1932x1932 · mydriatic (tropicamide phenylephrine 1.0%) — 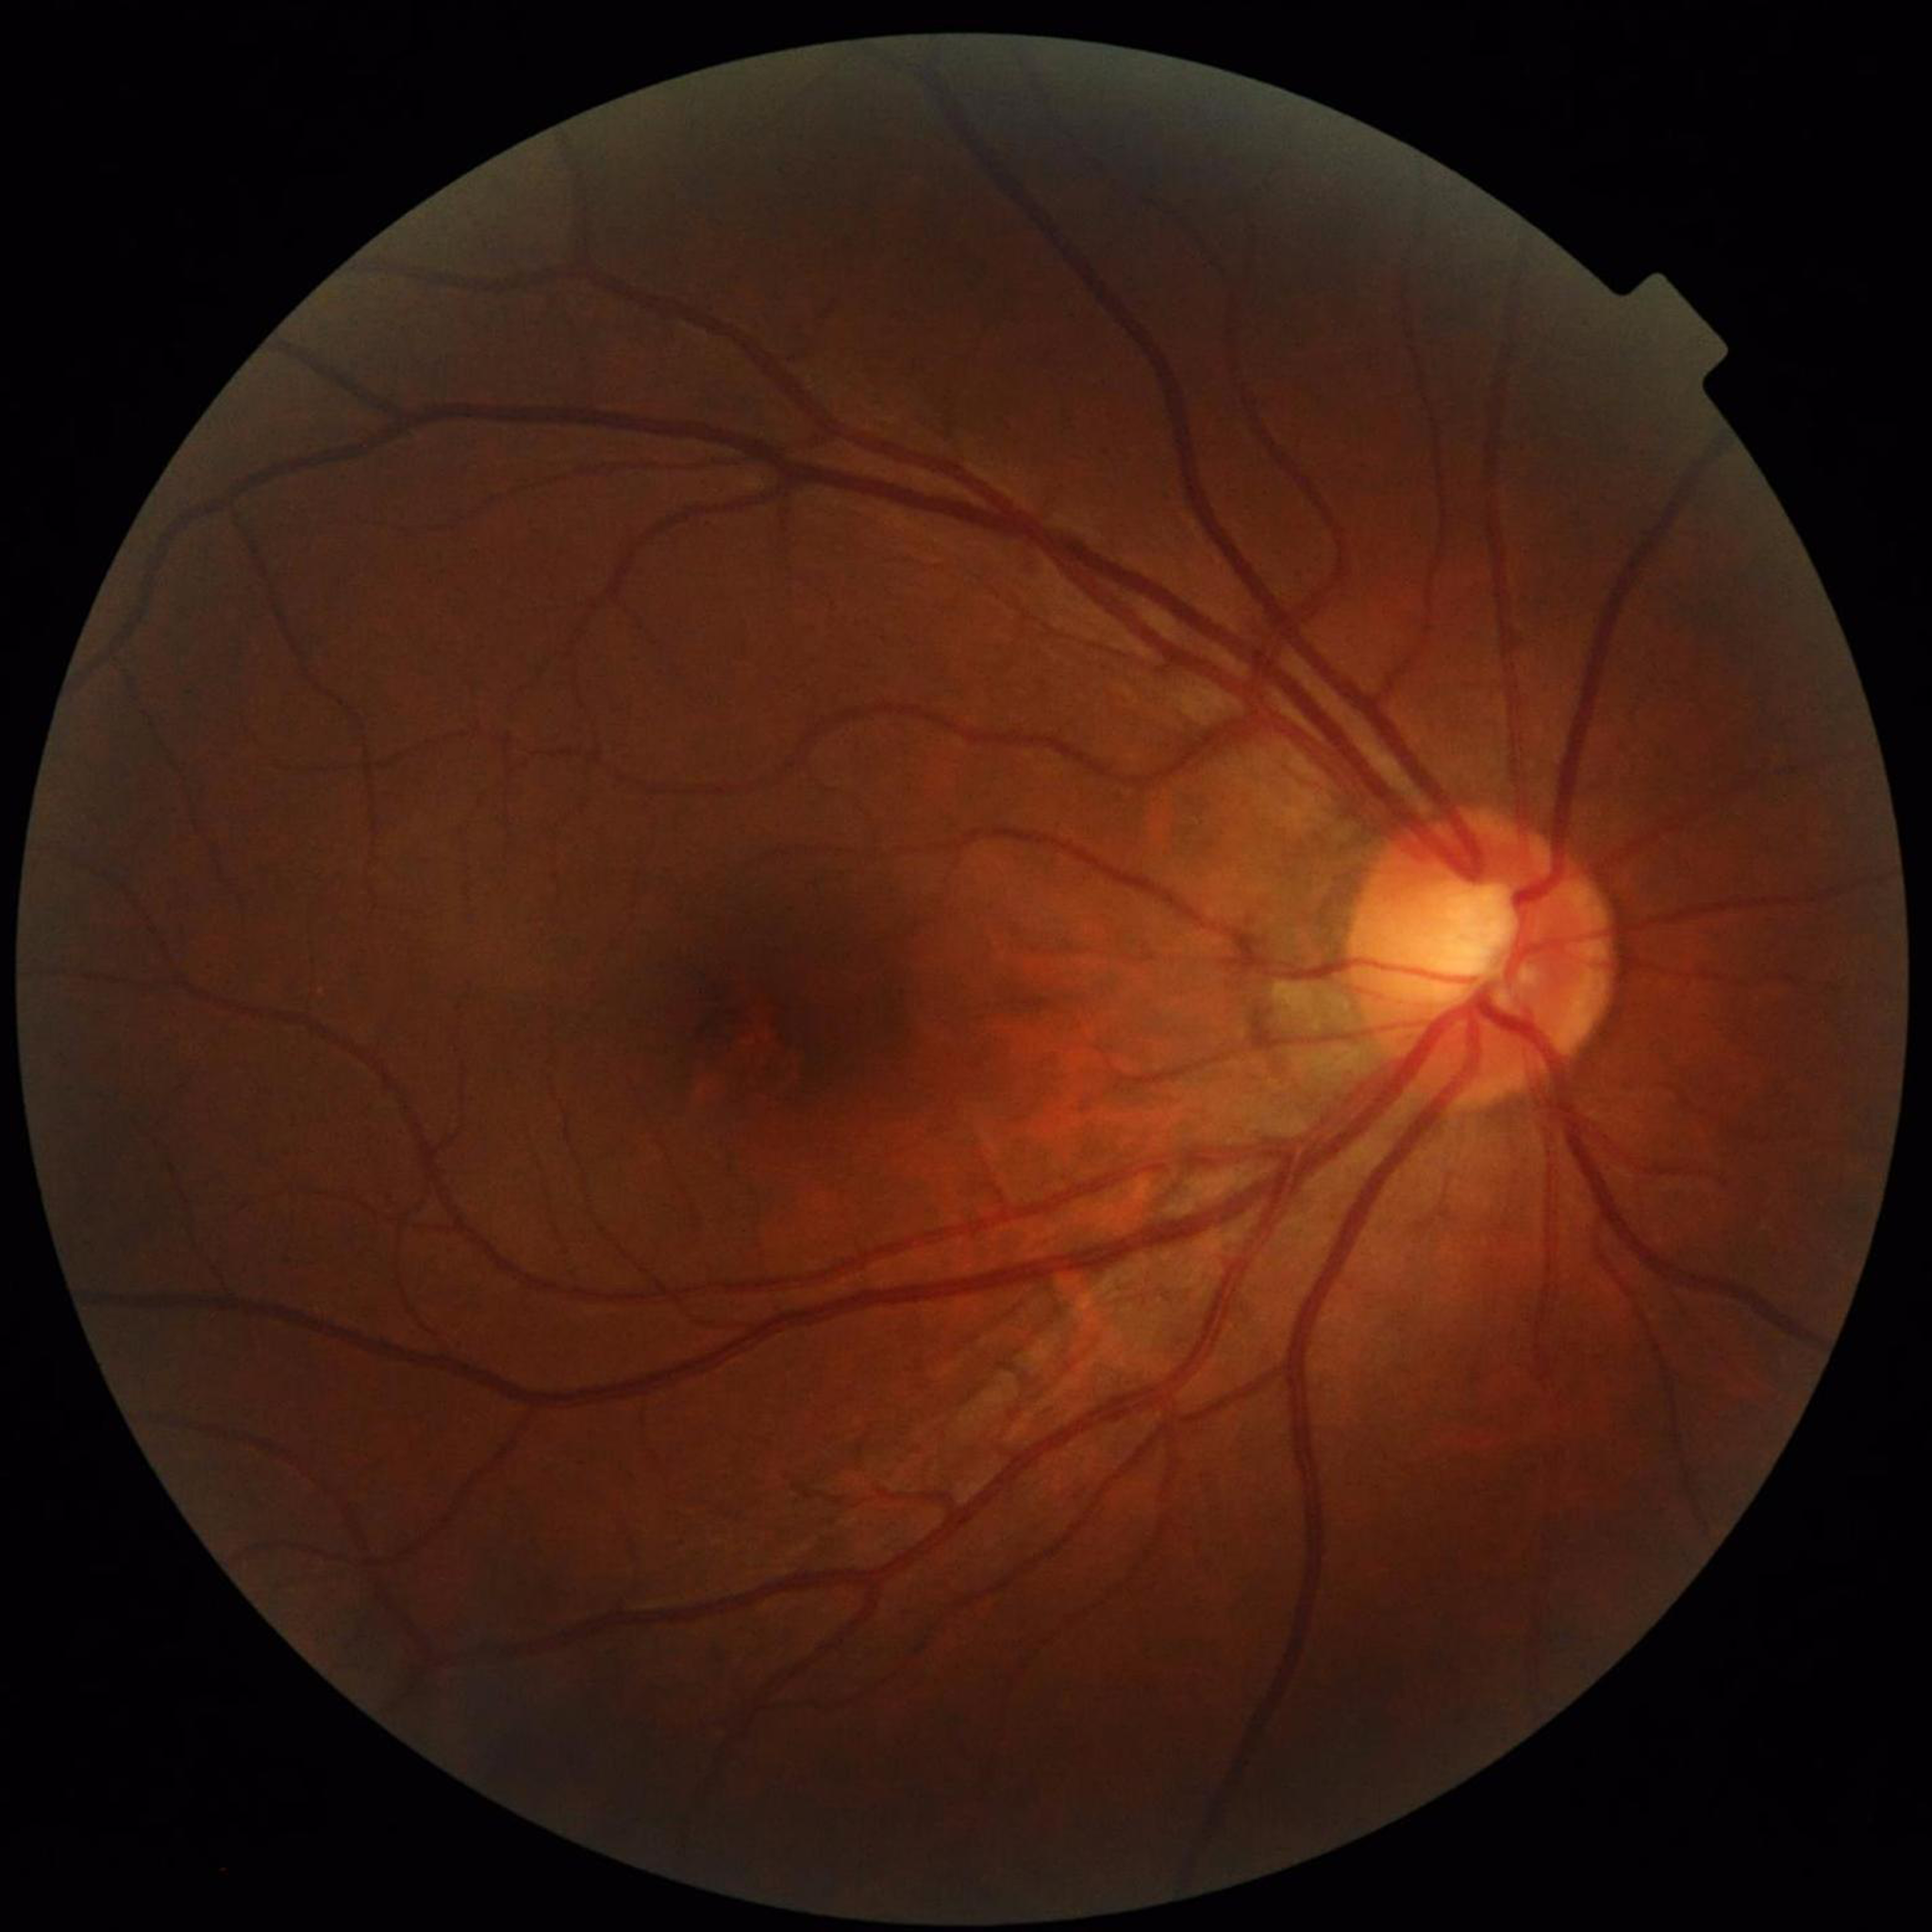 Diagnosis: glaucoma; Photo quality: concerns include illumination/color distortion.